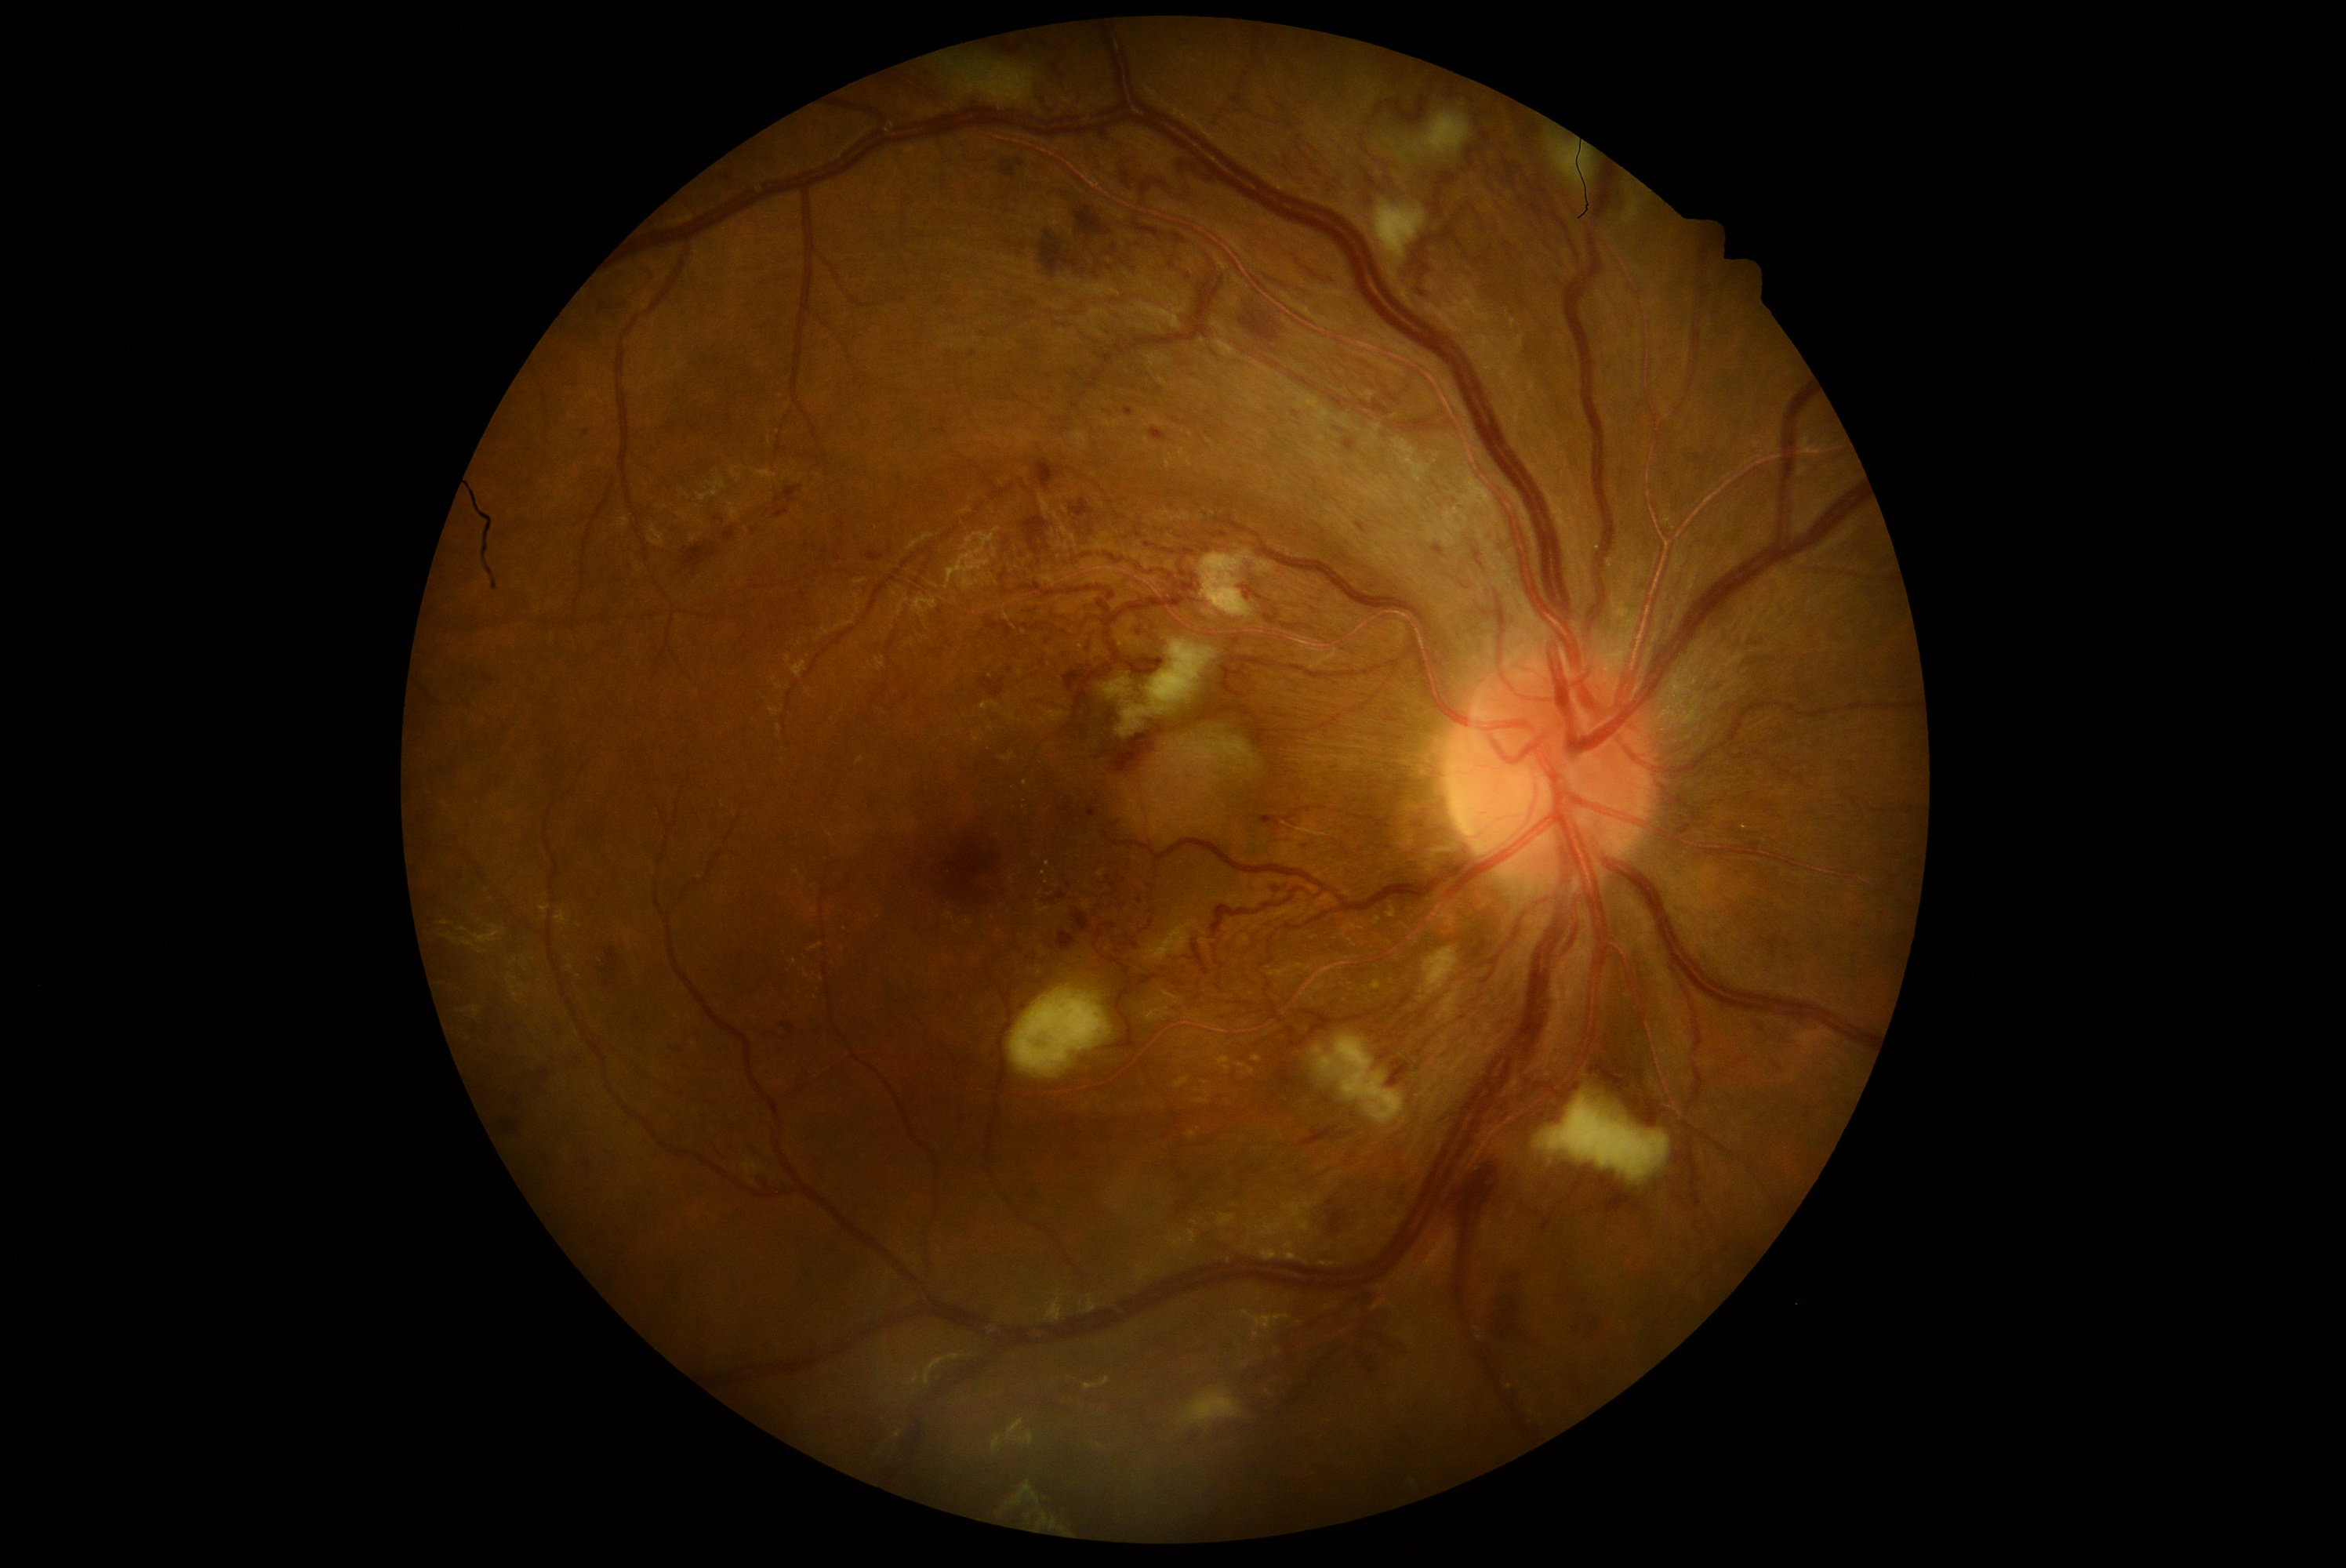 {"partial":true,"dr_grade":3,"dr_grade_name":"severe NPDR","lesions":{"ma":[[1433,545,1447,557],[1125,408,1135,416],[583,429,590,437],[1343,440,1357,454]],"ma_small_centers":[[1196,377],[1295,413],[1184,365],[1340,429]],"ex":[[1216,1058,1232,1072],[1343,924,1362,931],[1237,1064,1257,1076],[1174,1076,1189,1089],[1371,981,1382,990],[1252,1056,1263,1064],[1196,1092,1211,1105],[1387,906,1395,920],[1375,916,1381,924]],"ex_small_centers":[[1046,882],[1192,1136],[1207,1083],[1352,943],[1043,874],[1047,865],[1366,991],[1025,784],[1345,936],[1335,940]],"se":[[1011,989,1111,1076],[1375,200,1426,261],[1200,553,1254,619],[1404,112,1472,156],[1423,949,1453,996],[1313,1037,1404,1125],[1188,725,1237,750],[1199,741,1262,771],[1182,1388,1244,1429],[1624,197,1640,225],[1534,1094,1671,1181],[954,64,1036,106],[1544,132,1592,191],[1119,641,1216,736]],"he":[[501,1120,518,1134],[1109,244,1117,256],[978,677,1006,700],[1240,311,1282,343],[1589,1059,1668,1128],[600,948,623,981],[1273,887,1282,895],[1100,724,1166,775],[1329,1200,1337,1207],[1128,261,1136,277],[1067,670,1084,692],[722,528,736,542],[1059,802,1075,824],[1070,499,1095,518],[1056,891,1067,901],[1075,208,1111,238],[1089,264,1111,277]],"he_small_centers":[[1042,664]]}}